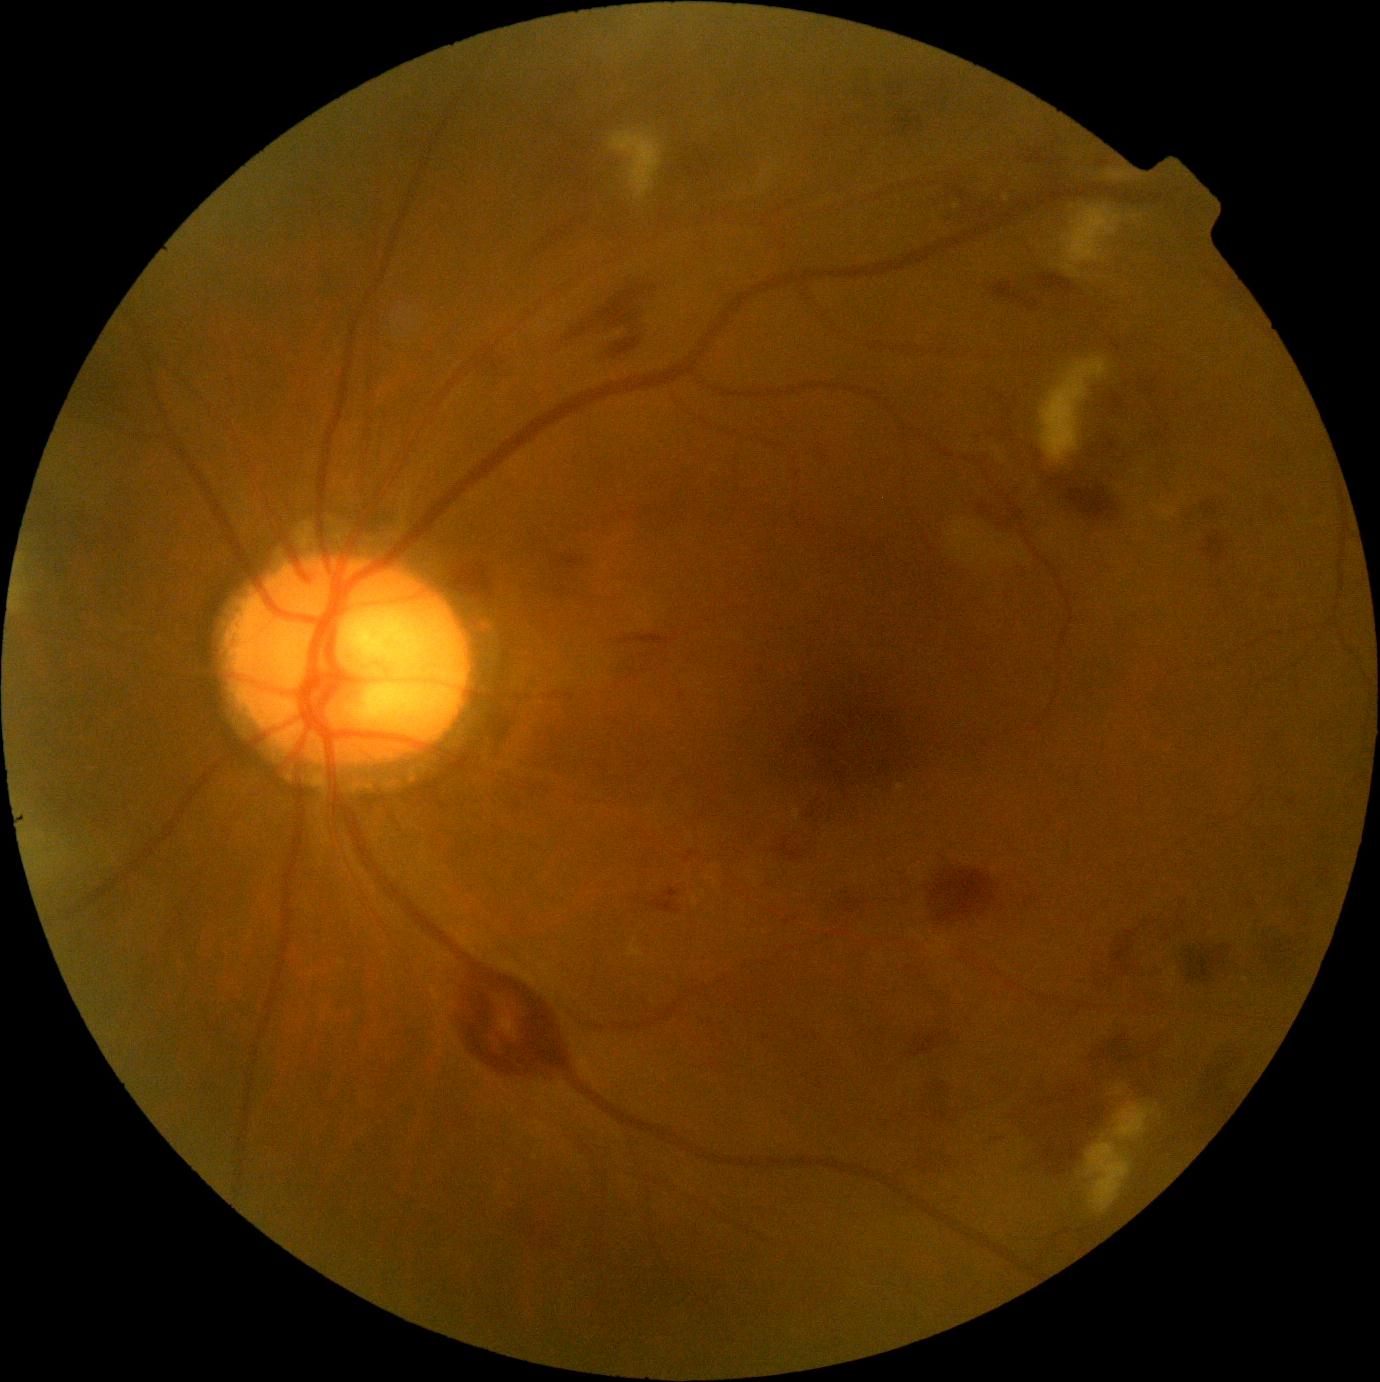

DR stage: grade 2 (moderate NPDR) — more than just microaneurysms but less than severe NPDR.